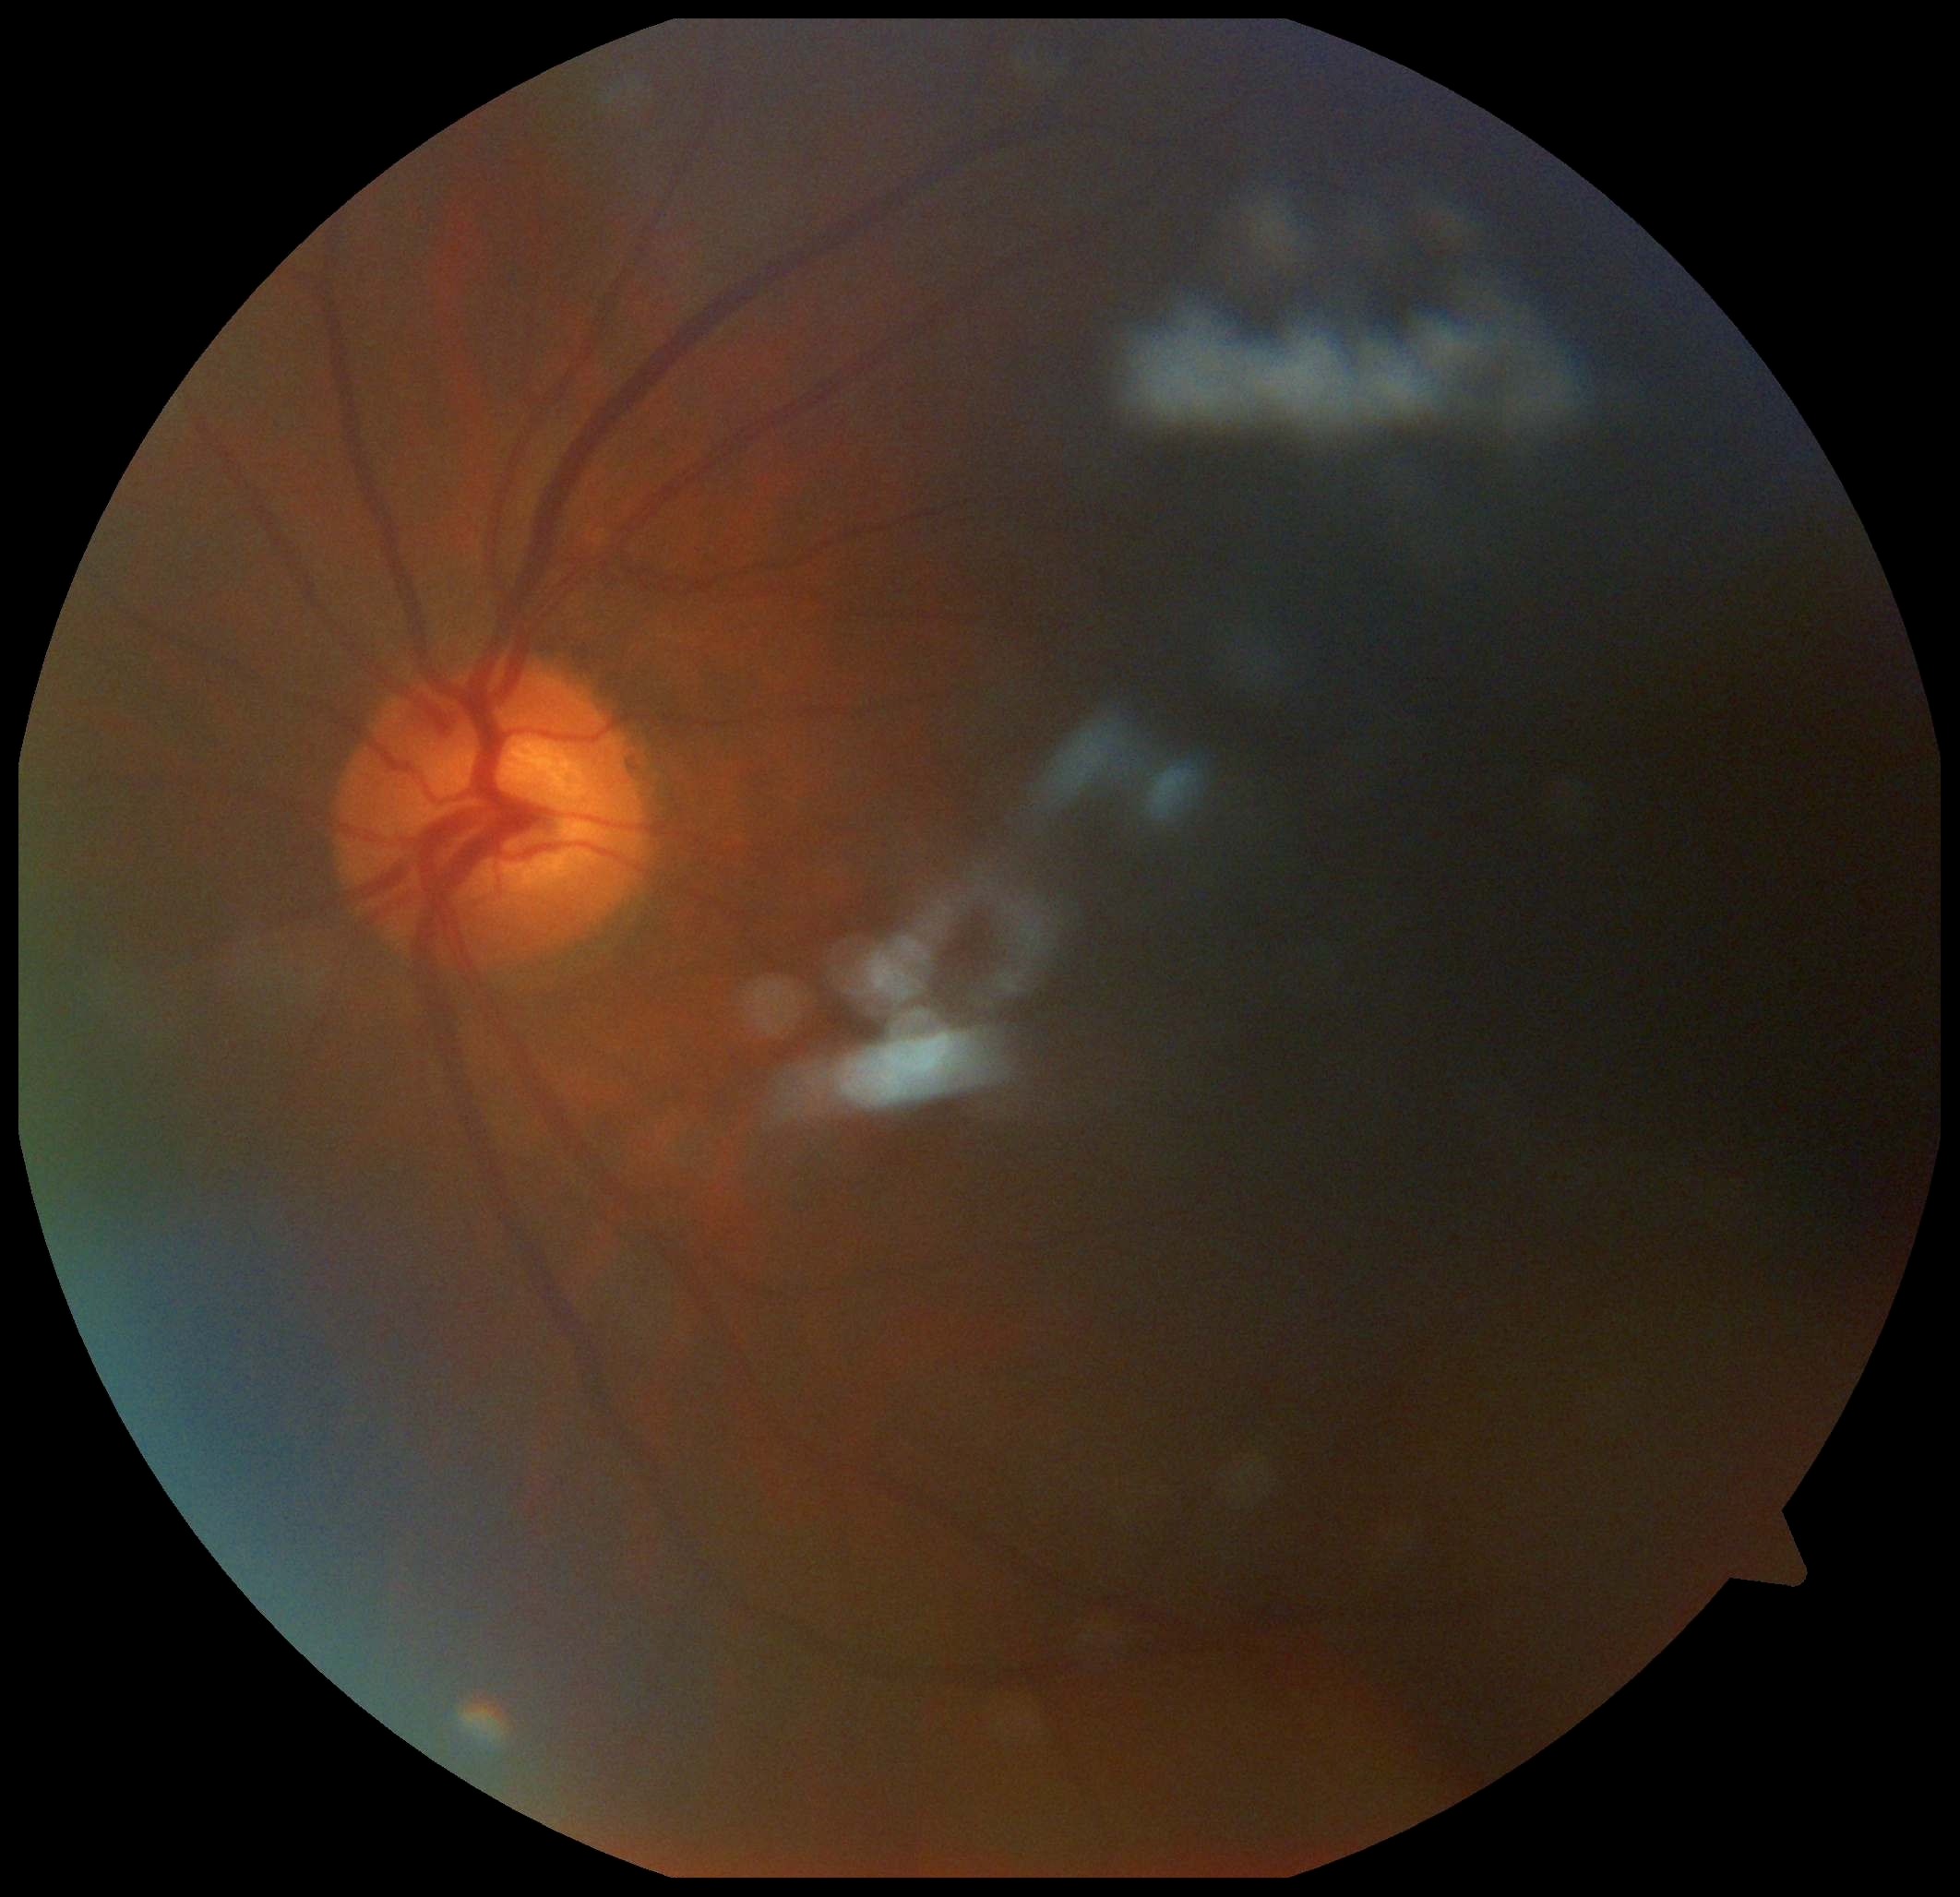 DR grade is ungradable due to poor image quality.